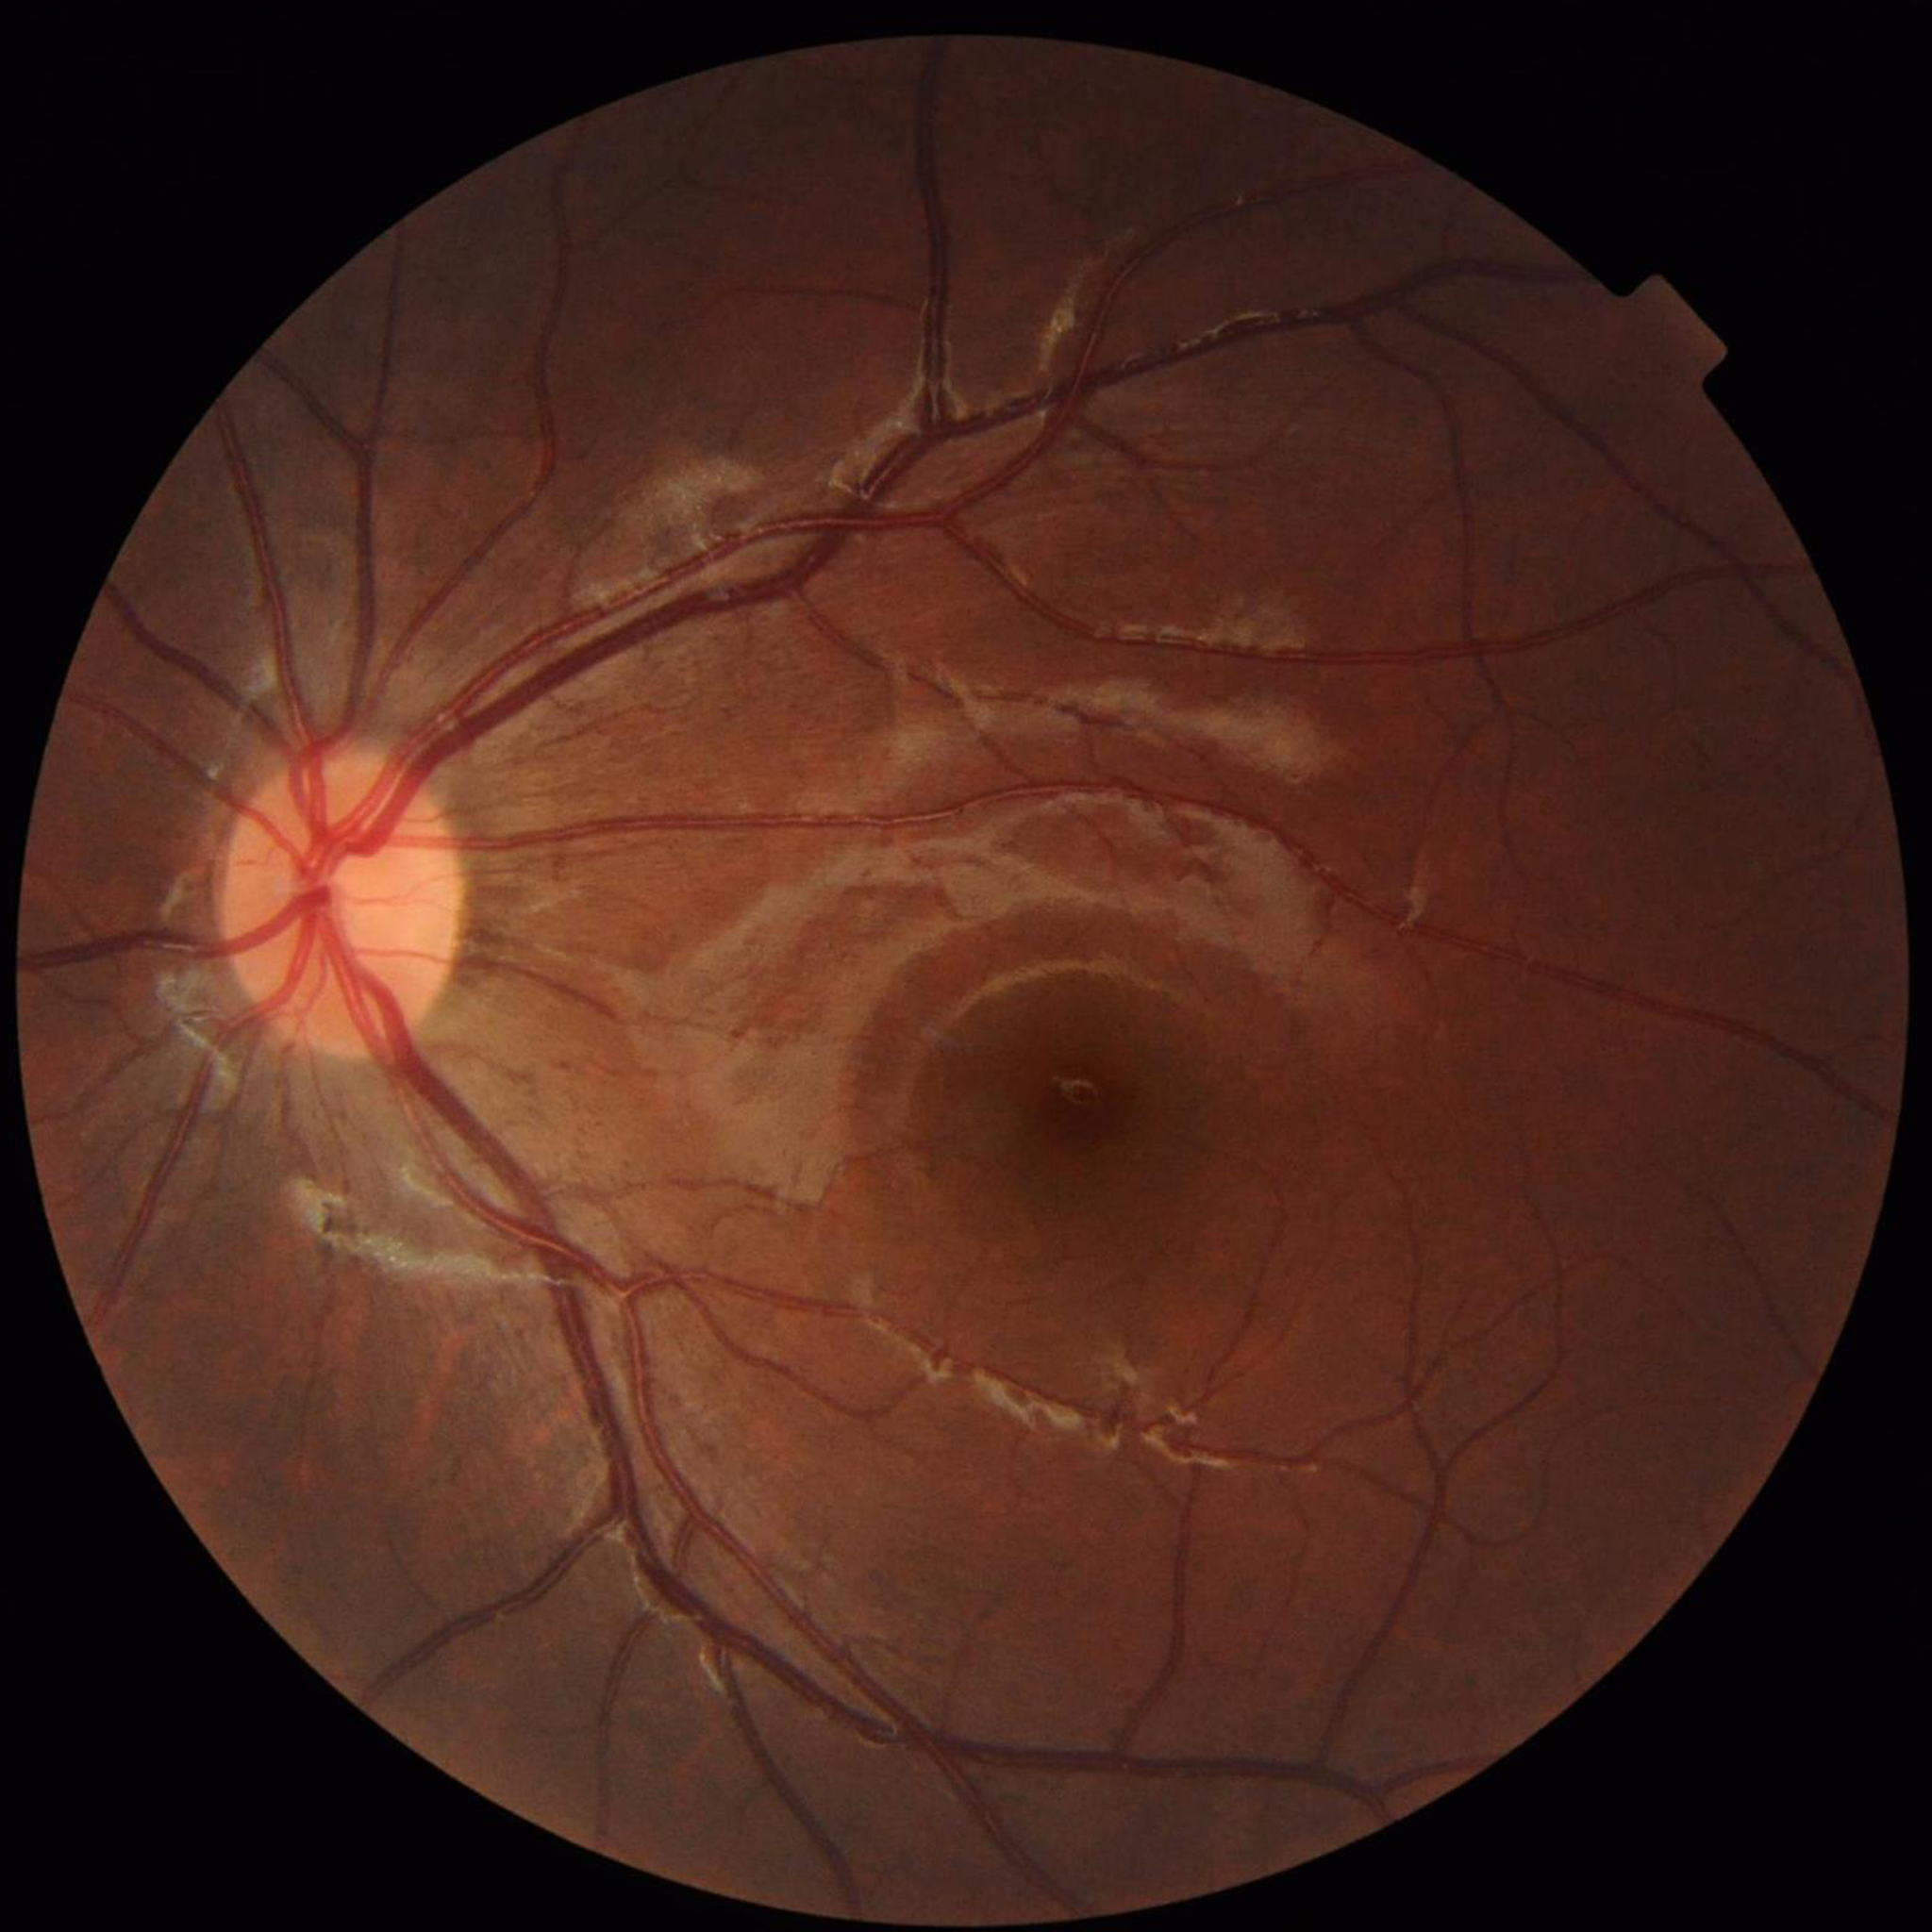 Diagnosis: diabetic retinopathy.